Modified Davis grading
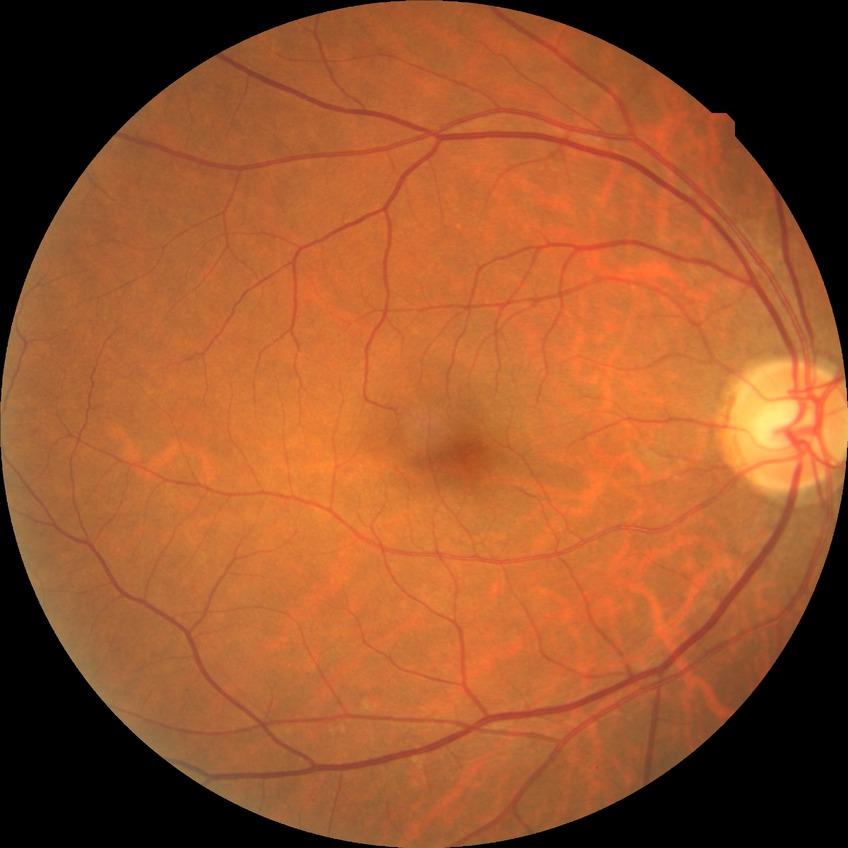 Diabetic retinopathy (DR): no diabetic retinopathy (NDR).